2228x1652, captured on a Topcon TRC-50DX fundus camera
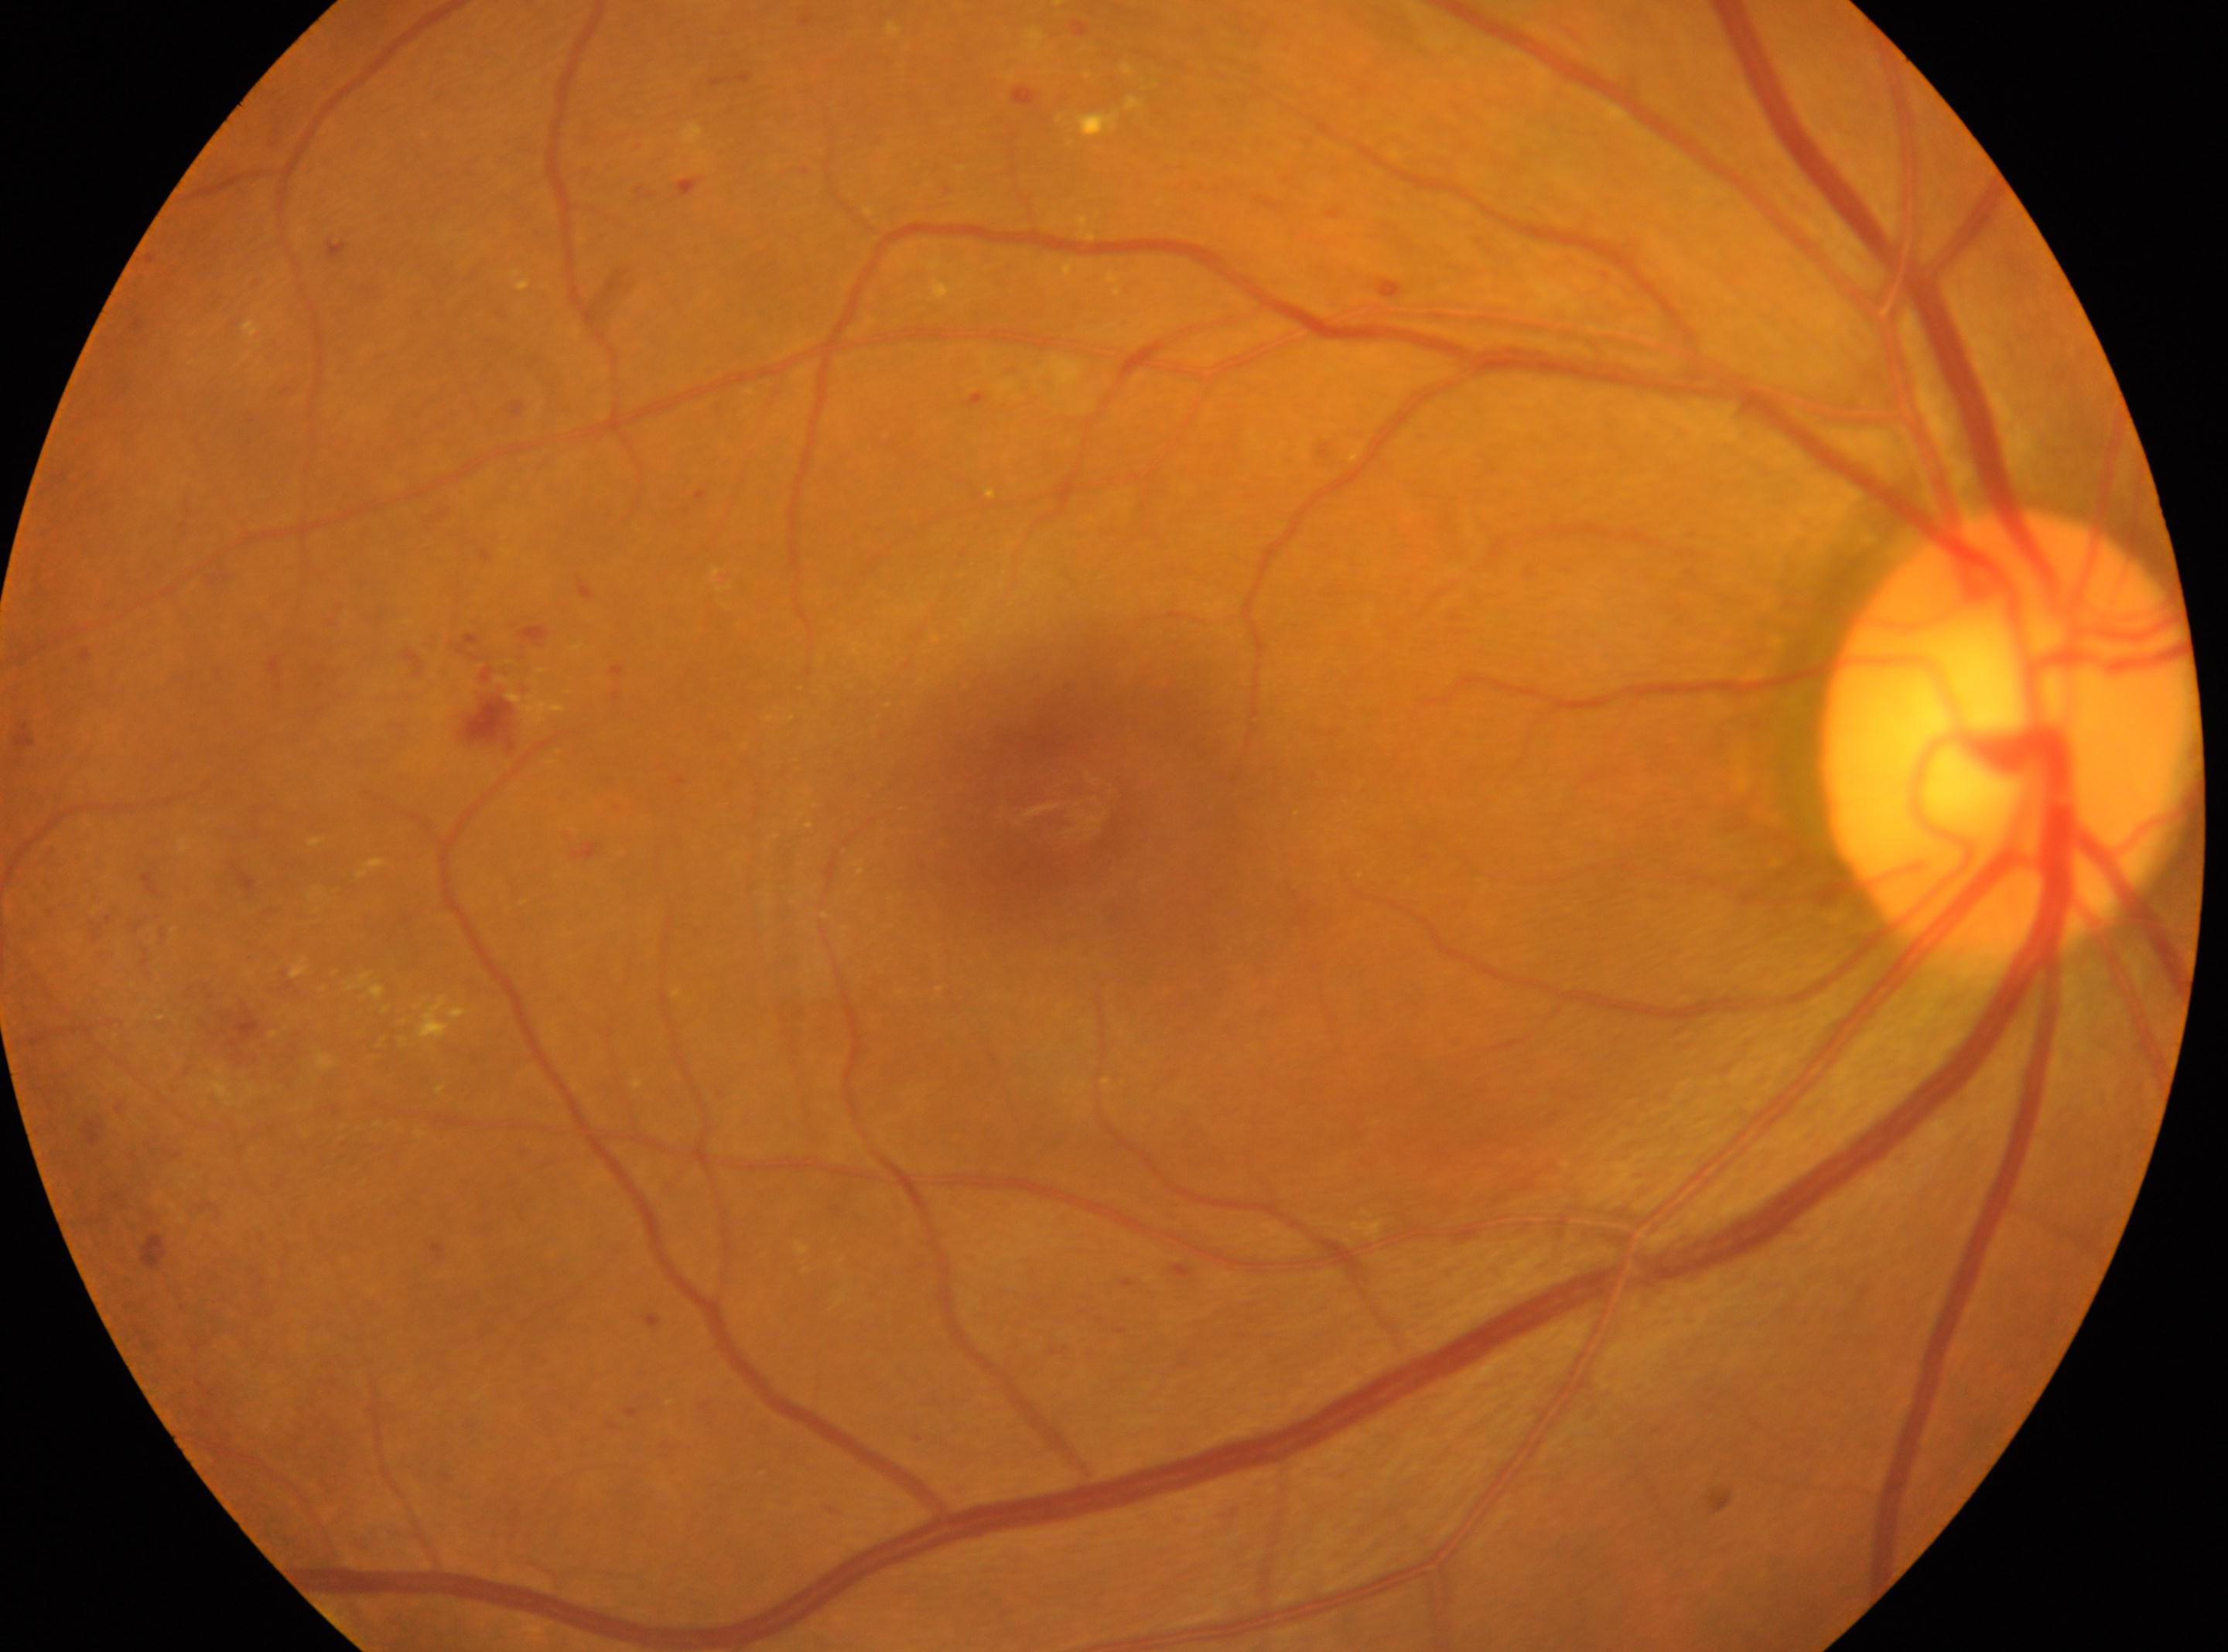 {"fovea": "1057px, 801px", "eye": "right eye", "optic_disc": "2007px, 732px", "dr_grade": "2 (moderate NPDR)"}